CFP, NIDEK AFC-230, nonmydriatic, FOV: 45 degrees
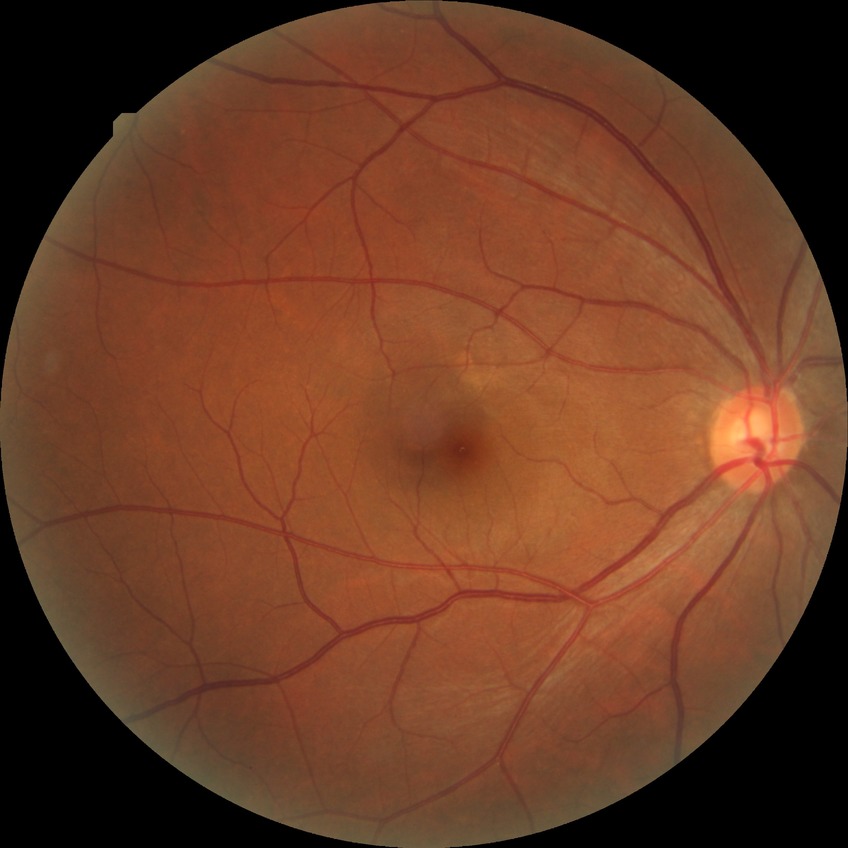 DR is NDR.